Captured without pupil dilation:
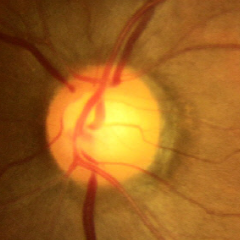

Fundus image with findings of no evidence of glaucoma.